45 degree fundus photograph; 848 x 848 pixels — 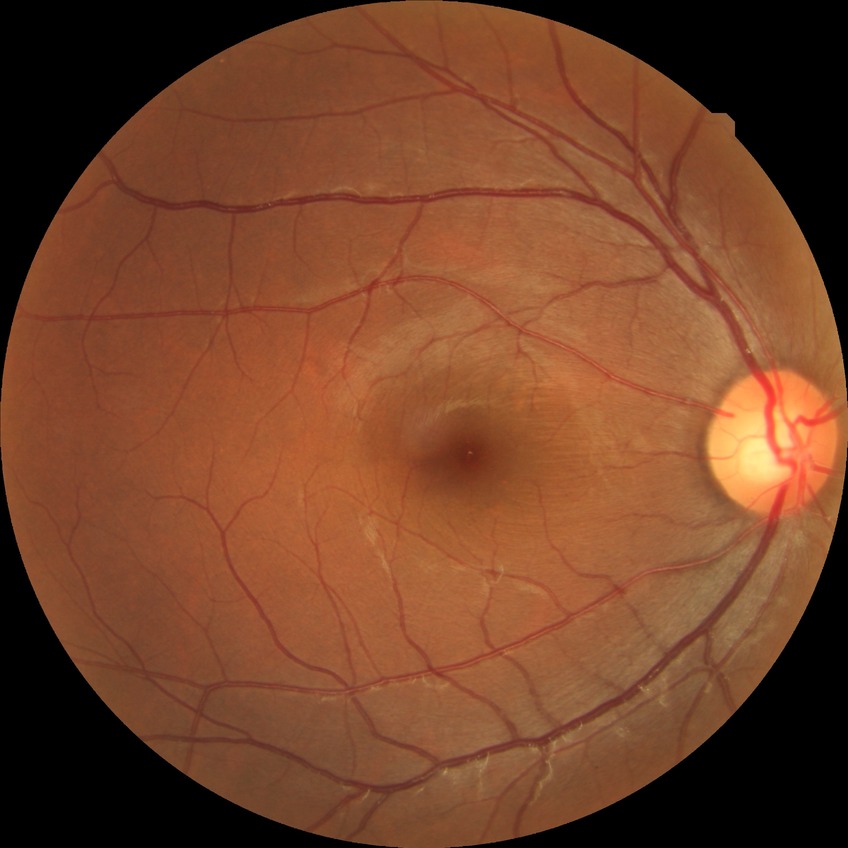 {"davis_grade": "NDR (no diabetic retinopathy)"}